No pharmacologic dilation: 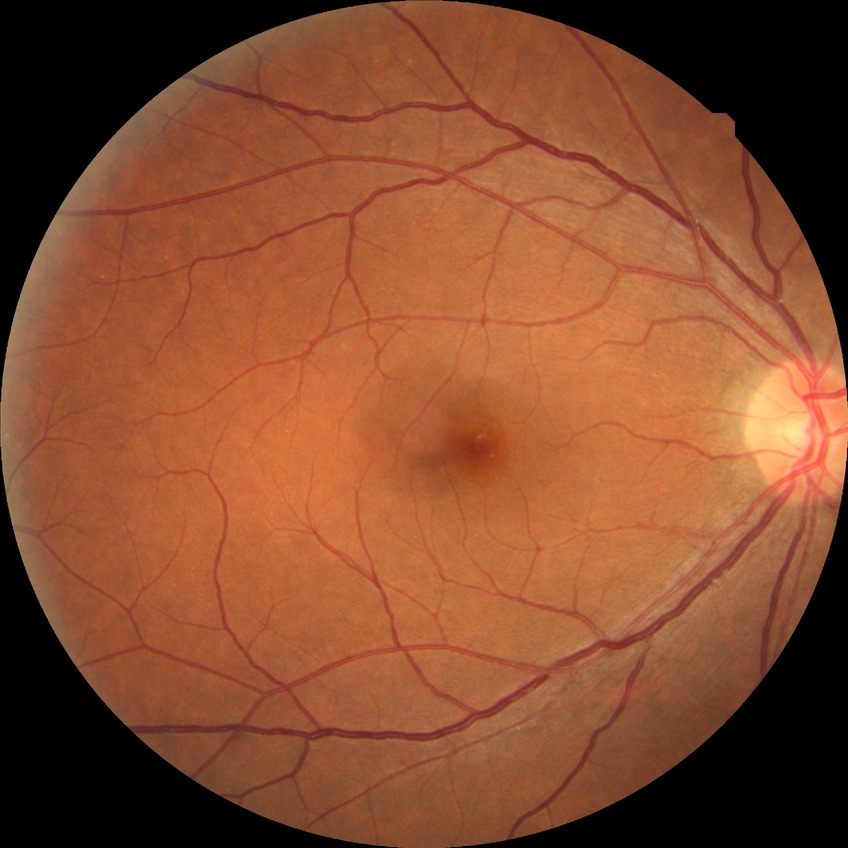
Diabetic retinopathy (DR): NDR (no diabetic retinopathy).